45° field of view; 2212x1659px — 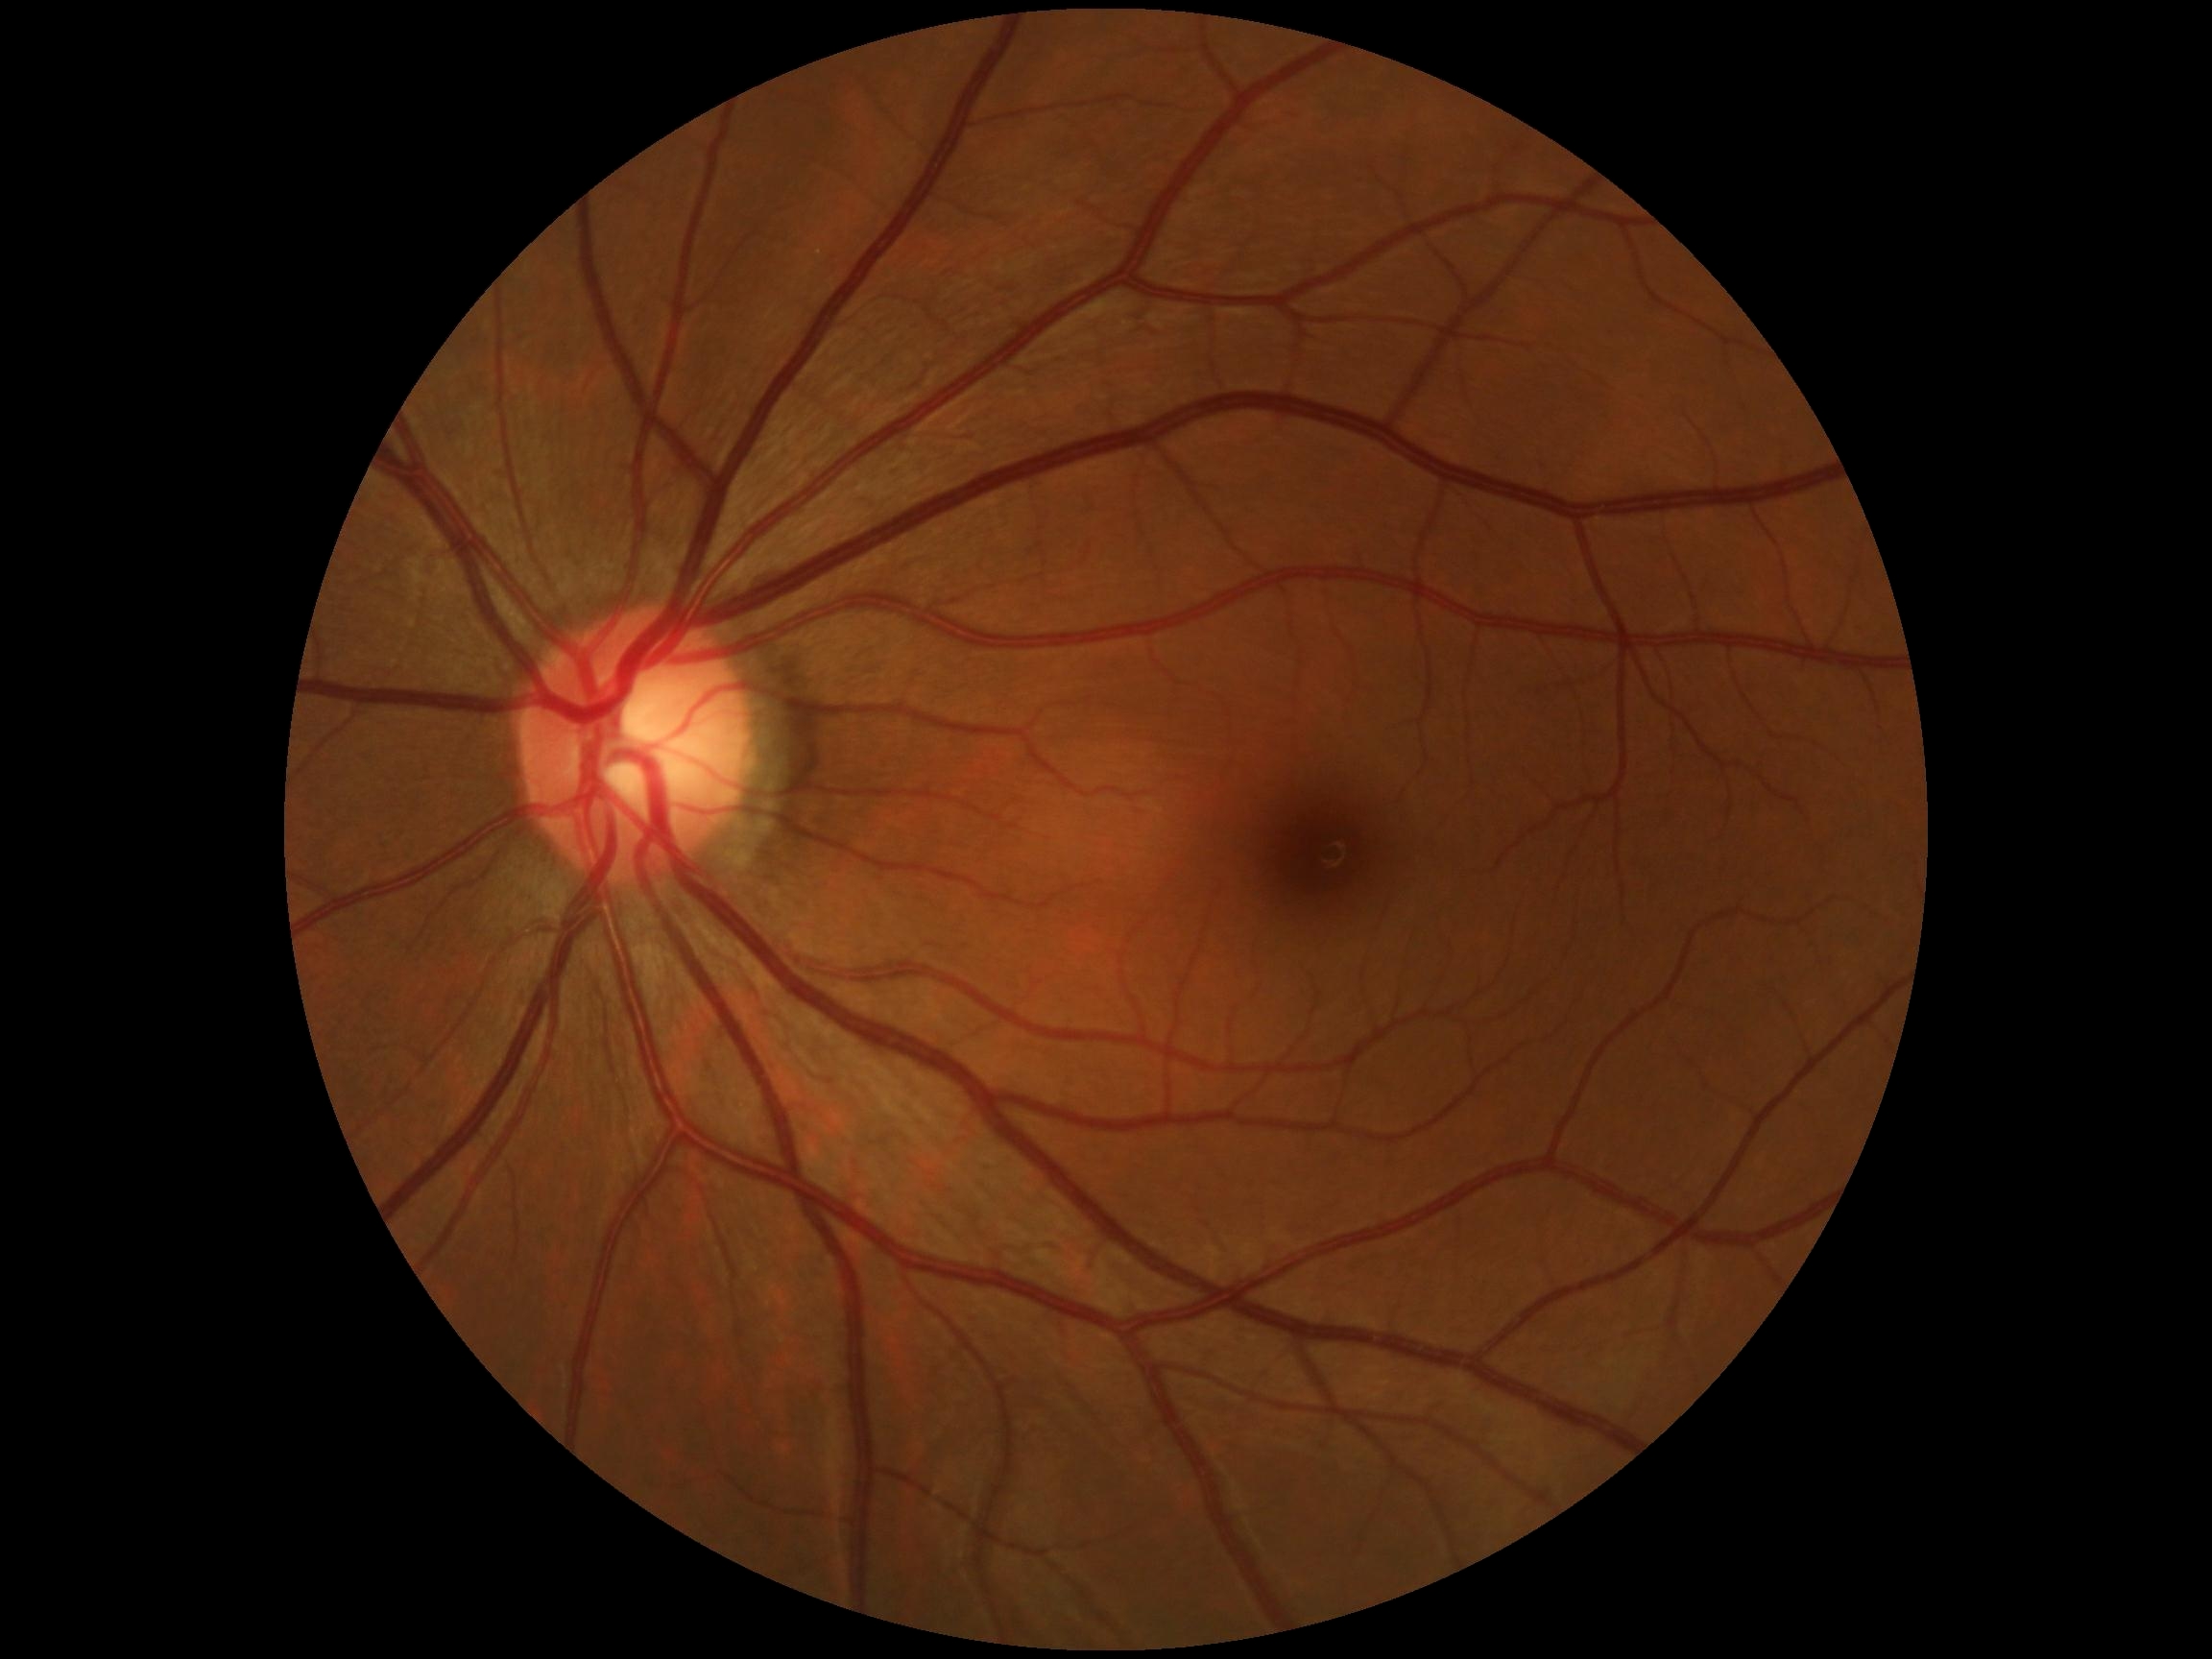
DR impression = negative for DR
DR grade = 0